Wide-field retinal mosaic image; 200° FOV: 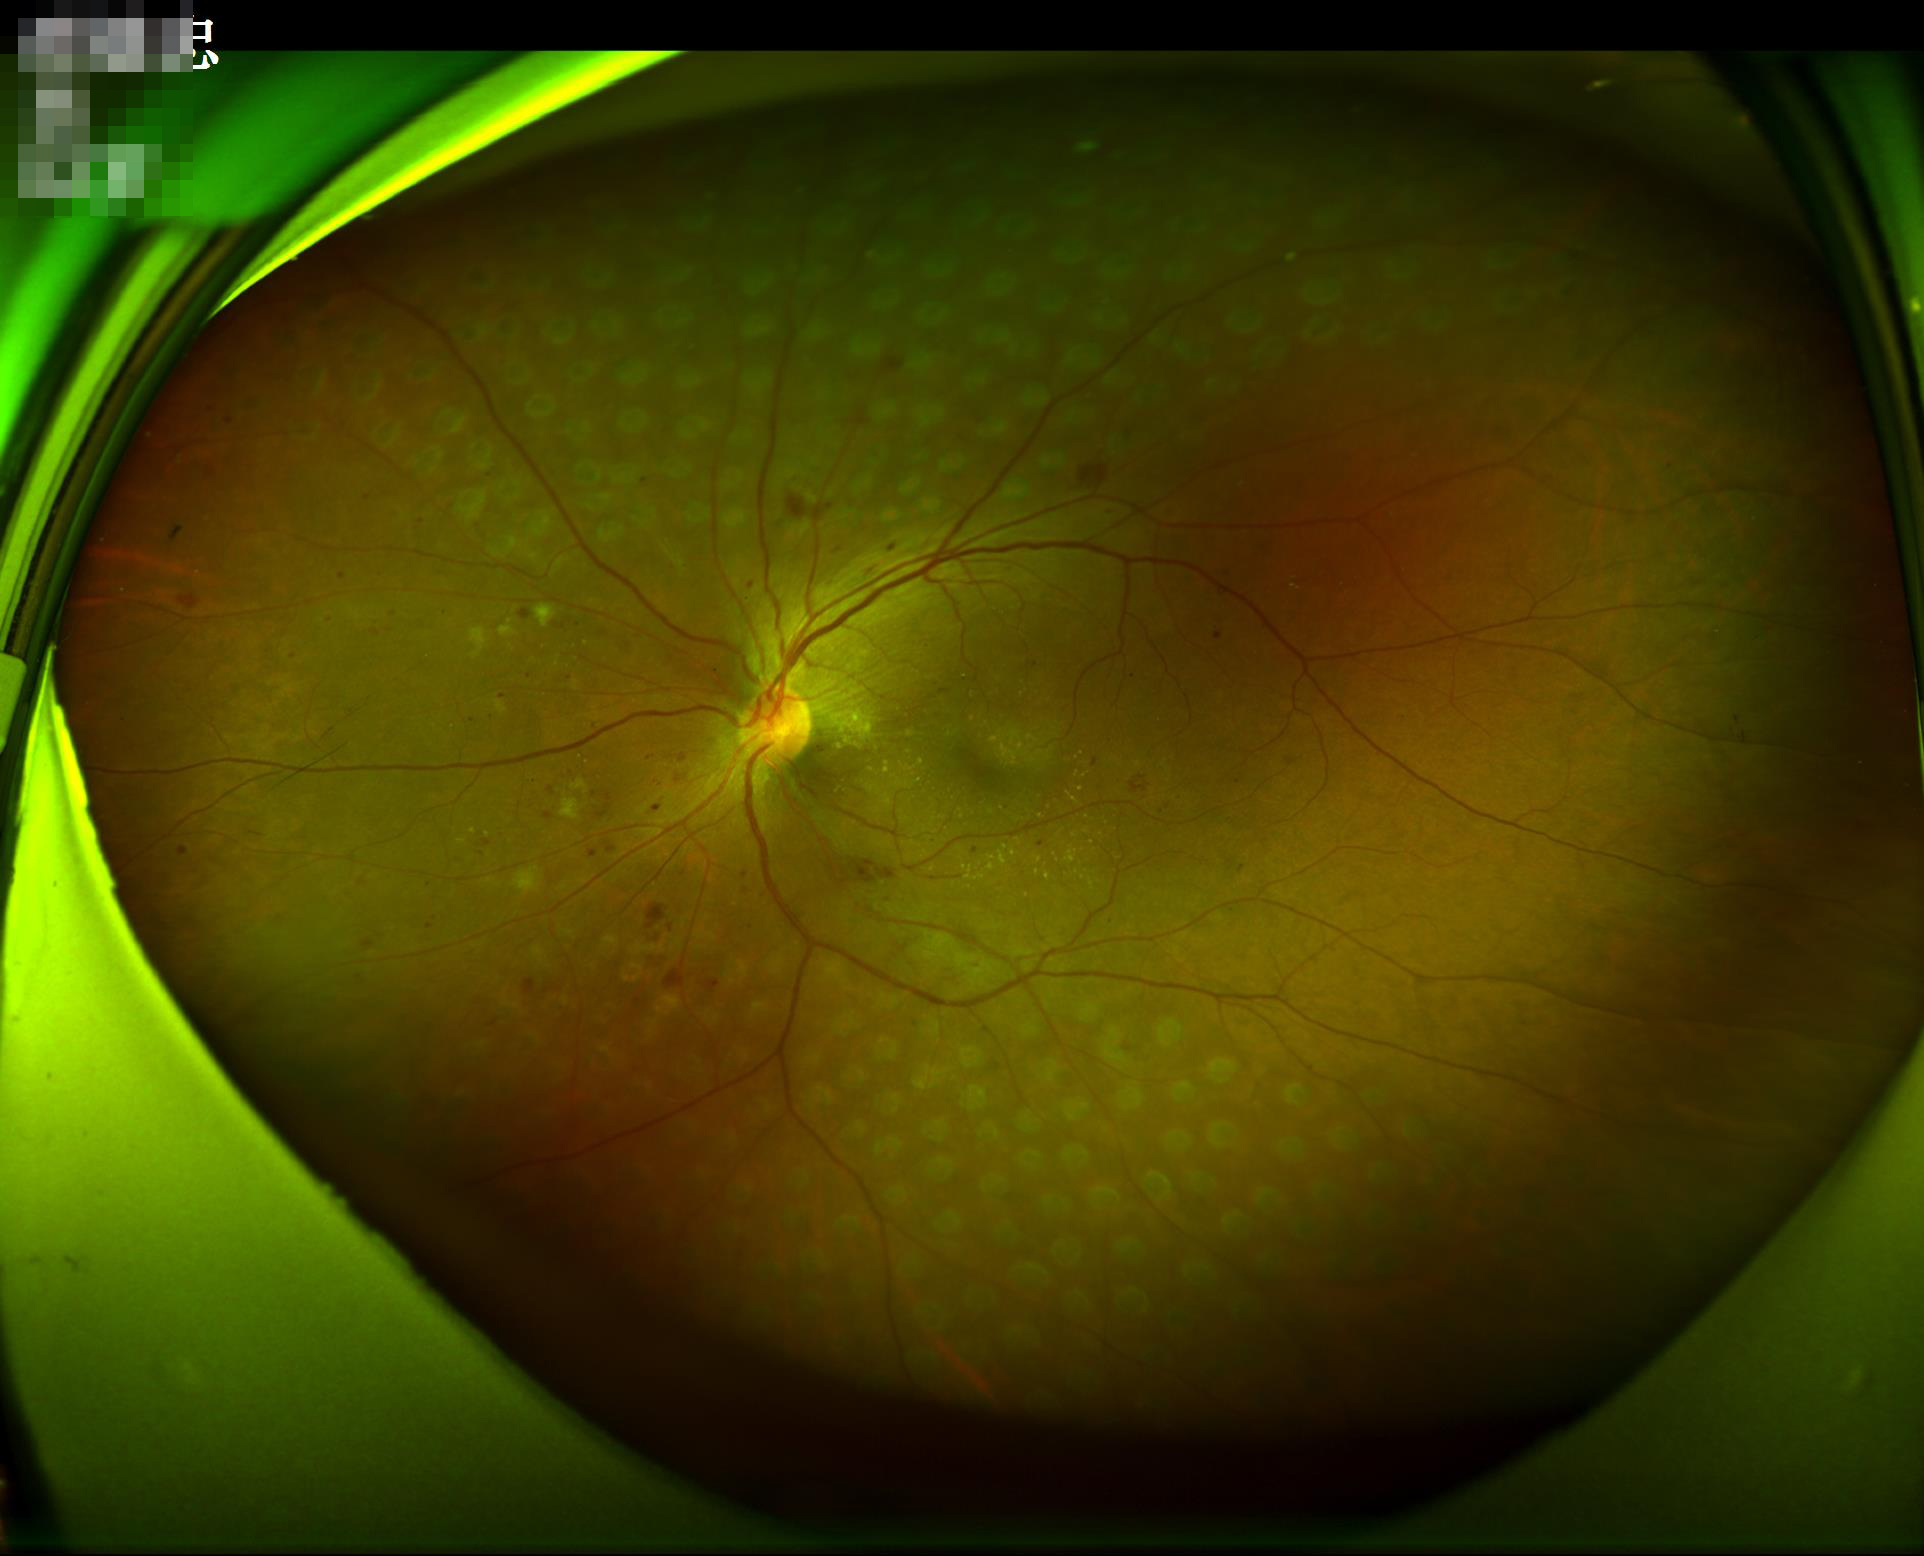

No over- or under-exposure. Optic disc, vessels, and background are in focus. Acceptable image quality. Good dynamic range.